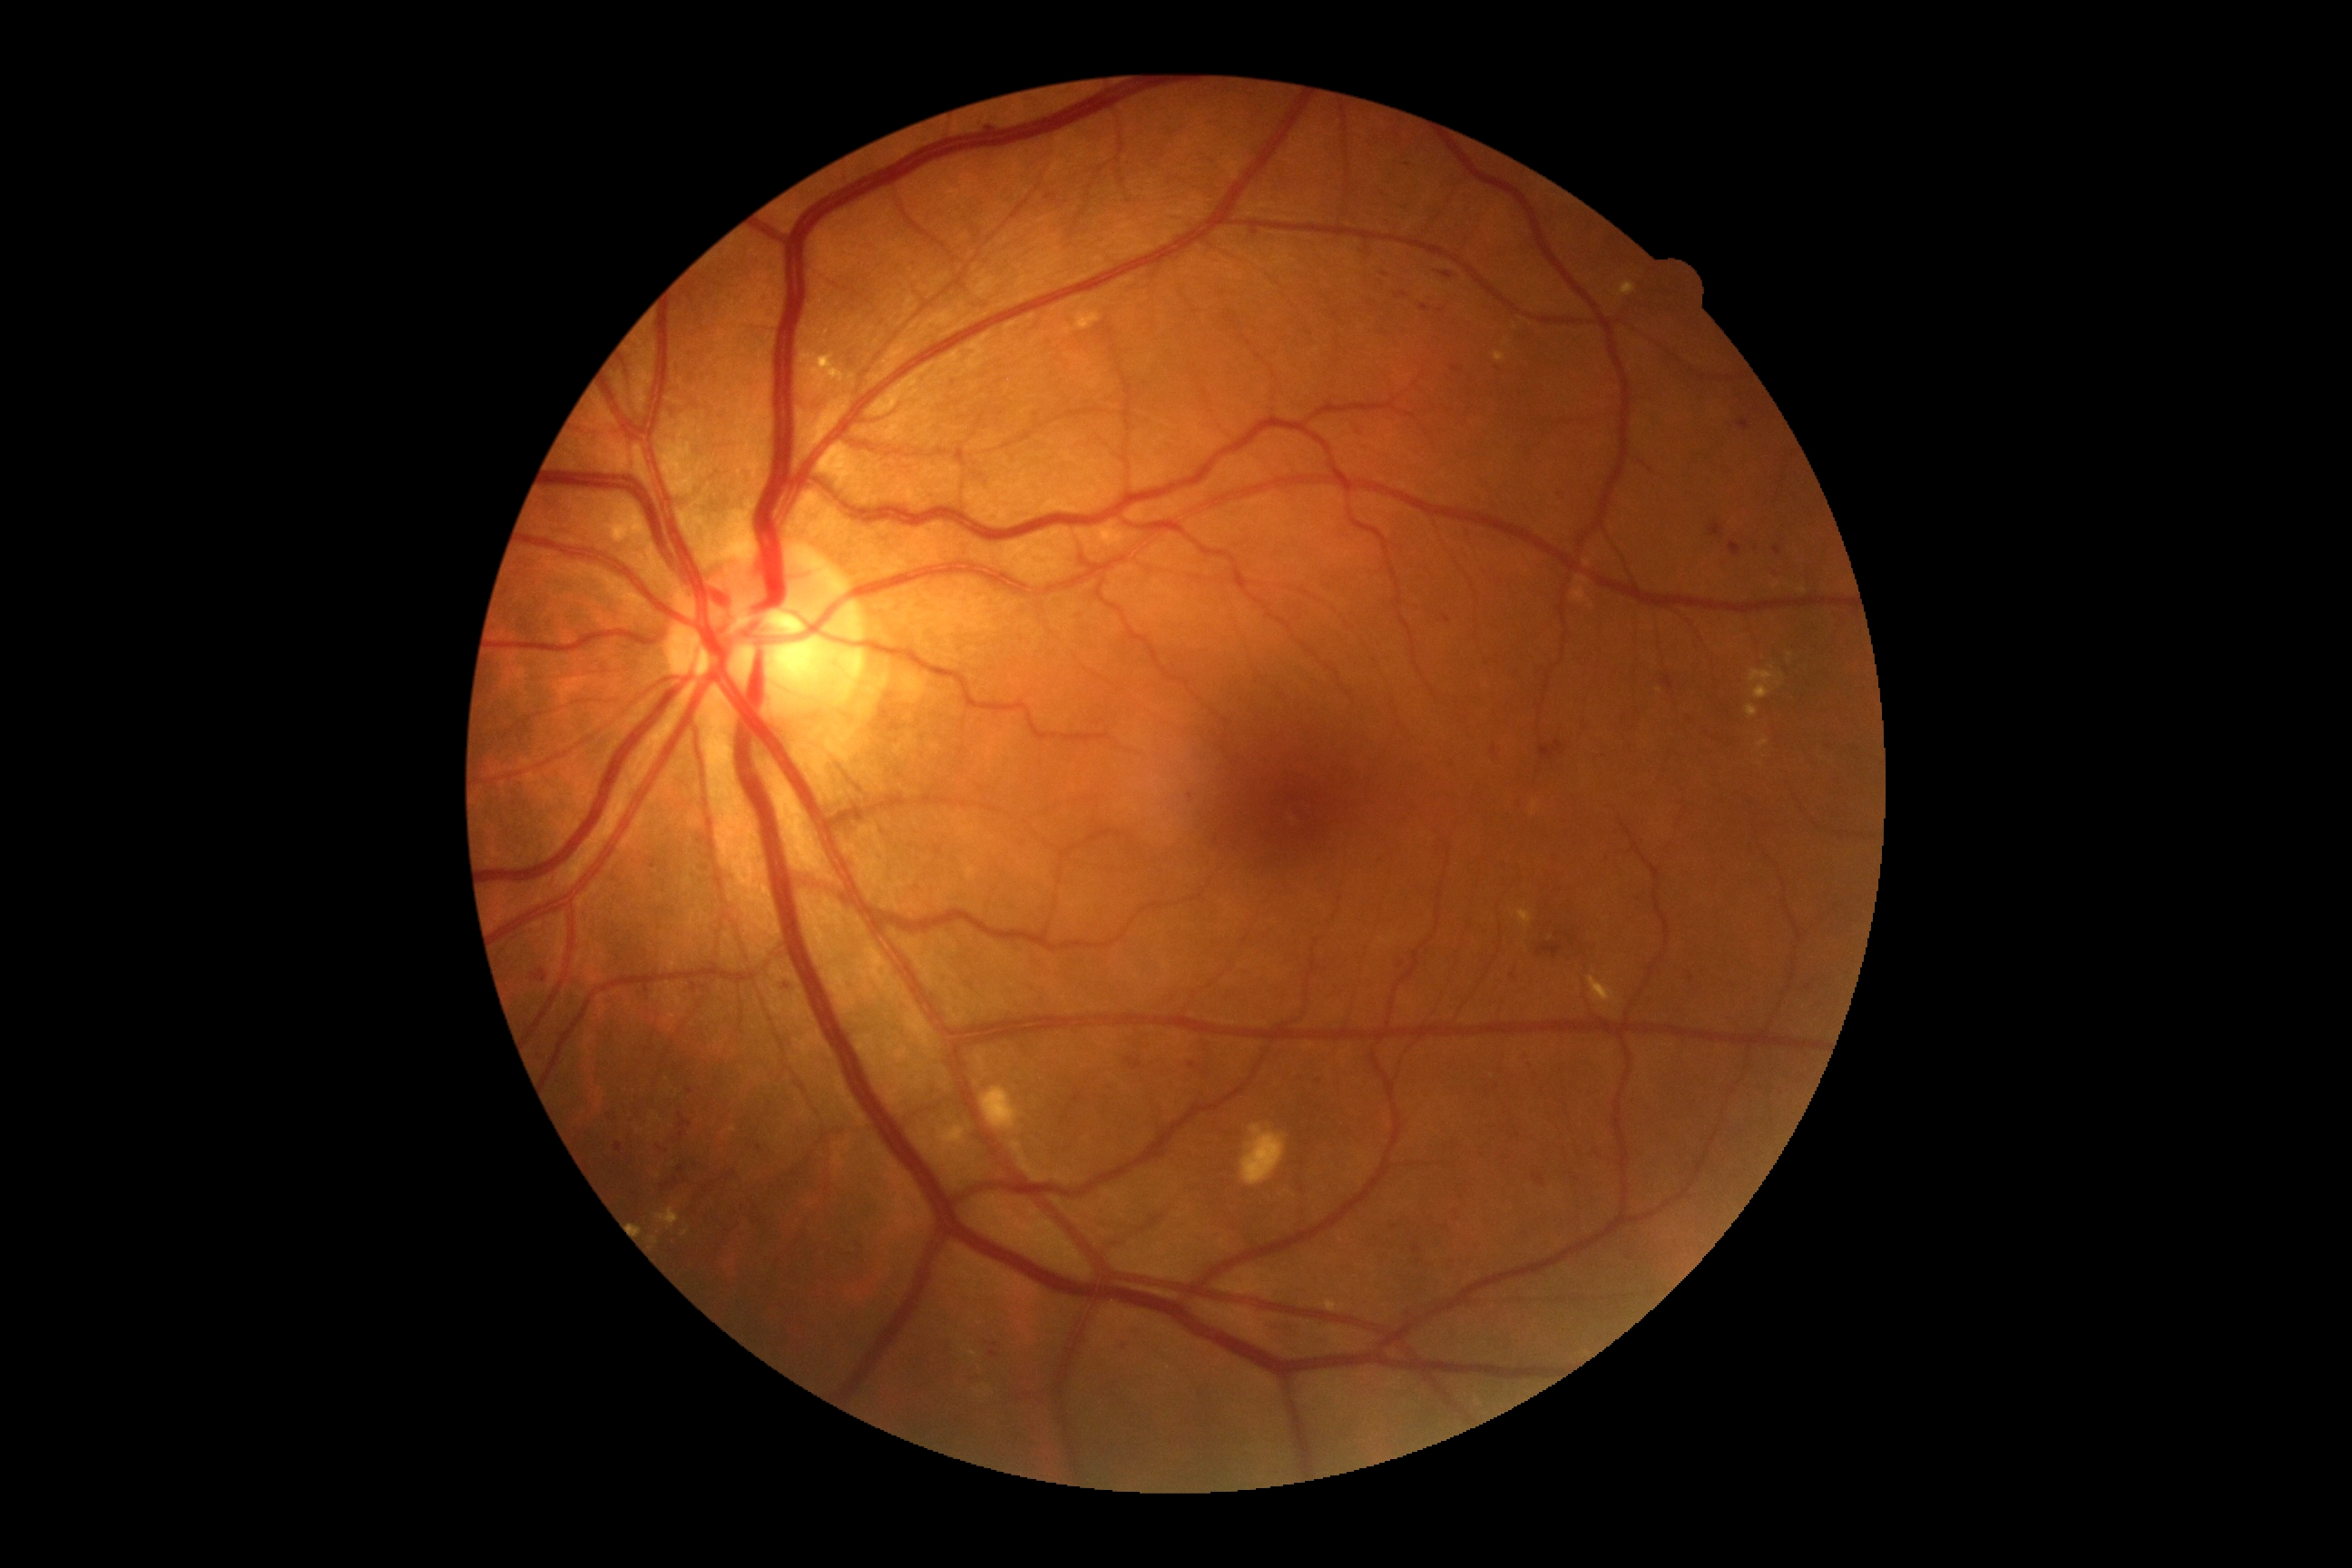 Retinopathy grade: 2 (moderate NPDR) — more than just microaneurysms but less than severe NPDR.